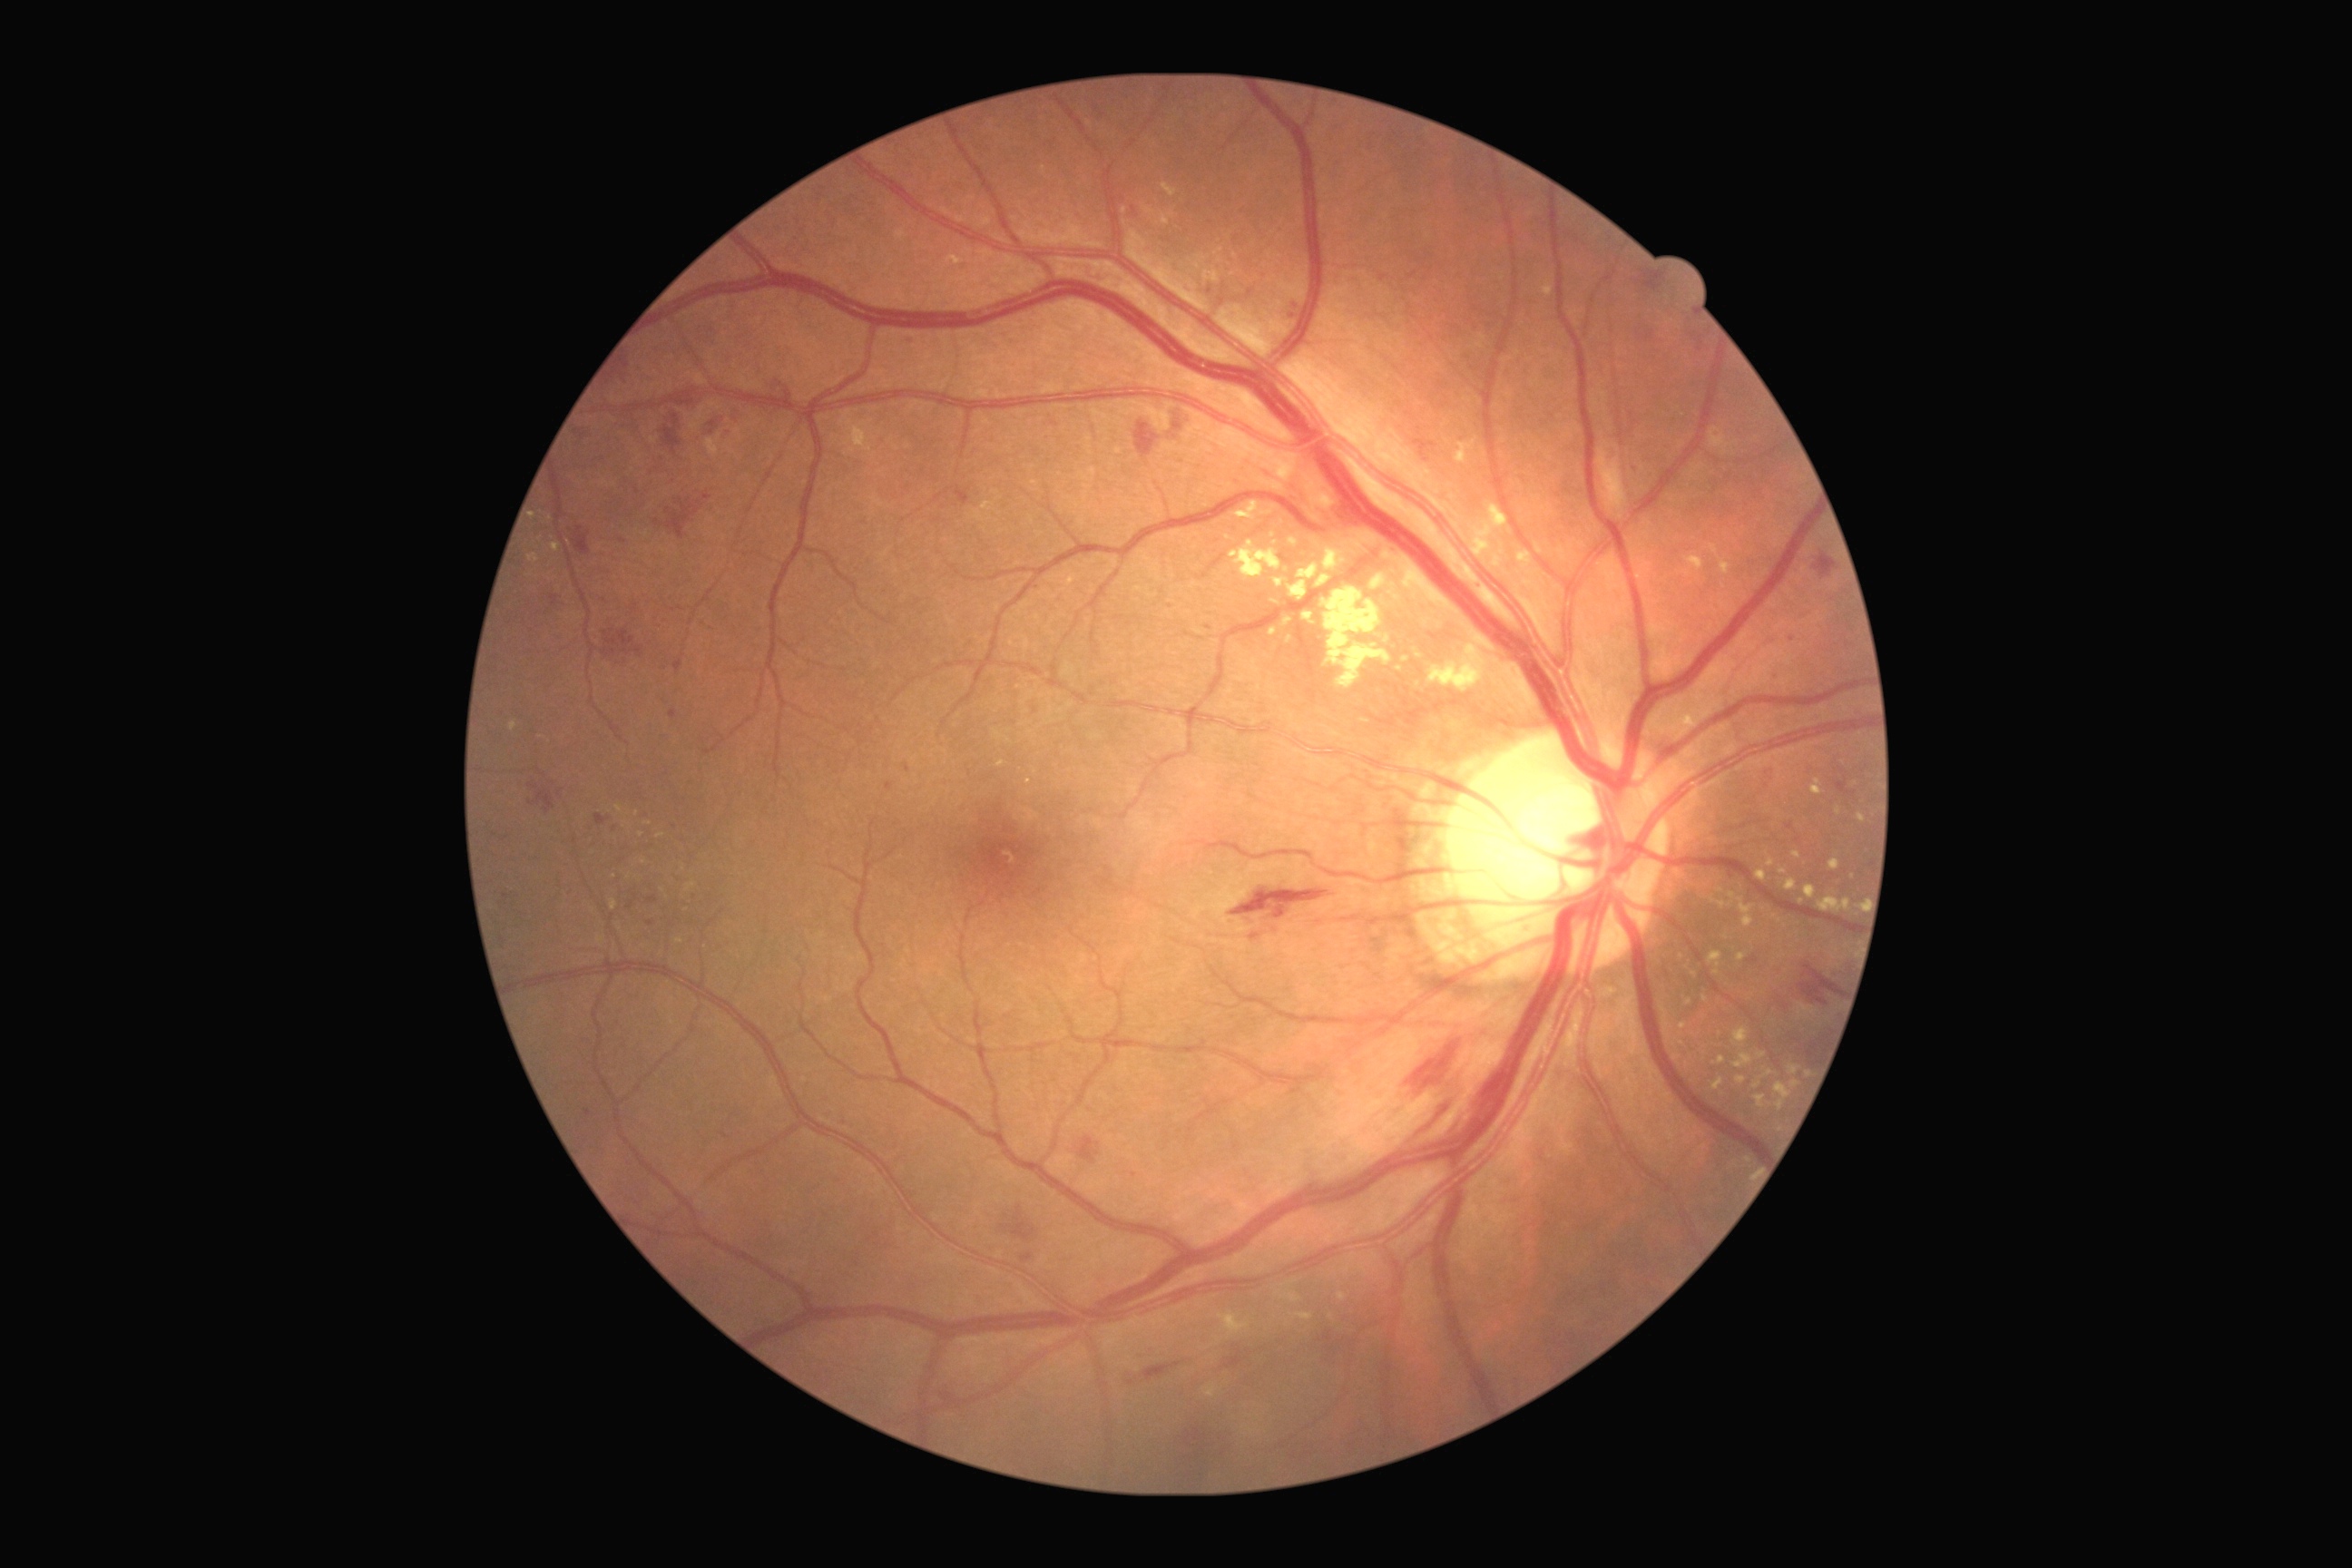 <lesions partial="true">
  <dr_grade>2</dr_grade>
  <ex partial="true"><bbox>1396, 667, 1404, 672</bbox> | <bbox>1857, 812, 1867, 823</bbox> | <bbox>1289, 538, 1298, 545</bbox> | <bbox>1756, 870, 1767, 883</bbox> | <bbox>1371, 574, 1386, 591</bbox> | <bbox>1269, 627, 1279, 638</bbox> | <bbox>1235, 502, 1260, 520</bbox> | <bbox>1710, 952, 1723, 965</bbox> | <bbox>687, 883, 696, 892</bbox> | <bbox>1286, 634, 1293, 645</bbox> | <bbox>1732, 1052, 1754, 1070</bbox> | <bbox>1792, 1081, 1801, 1088</bbox> | <bbox>1420, 660, 1482, 687</bbox> | <bbox>1317, 574, 1331, 587</bbox></ex>
  <ex_small_centers>644, 863 | 1029, 782 | 629, 877 | 1808, 1075 | 1754, 906</ex_small_centers>
</lesions>